1932 by 1910 pixels.
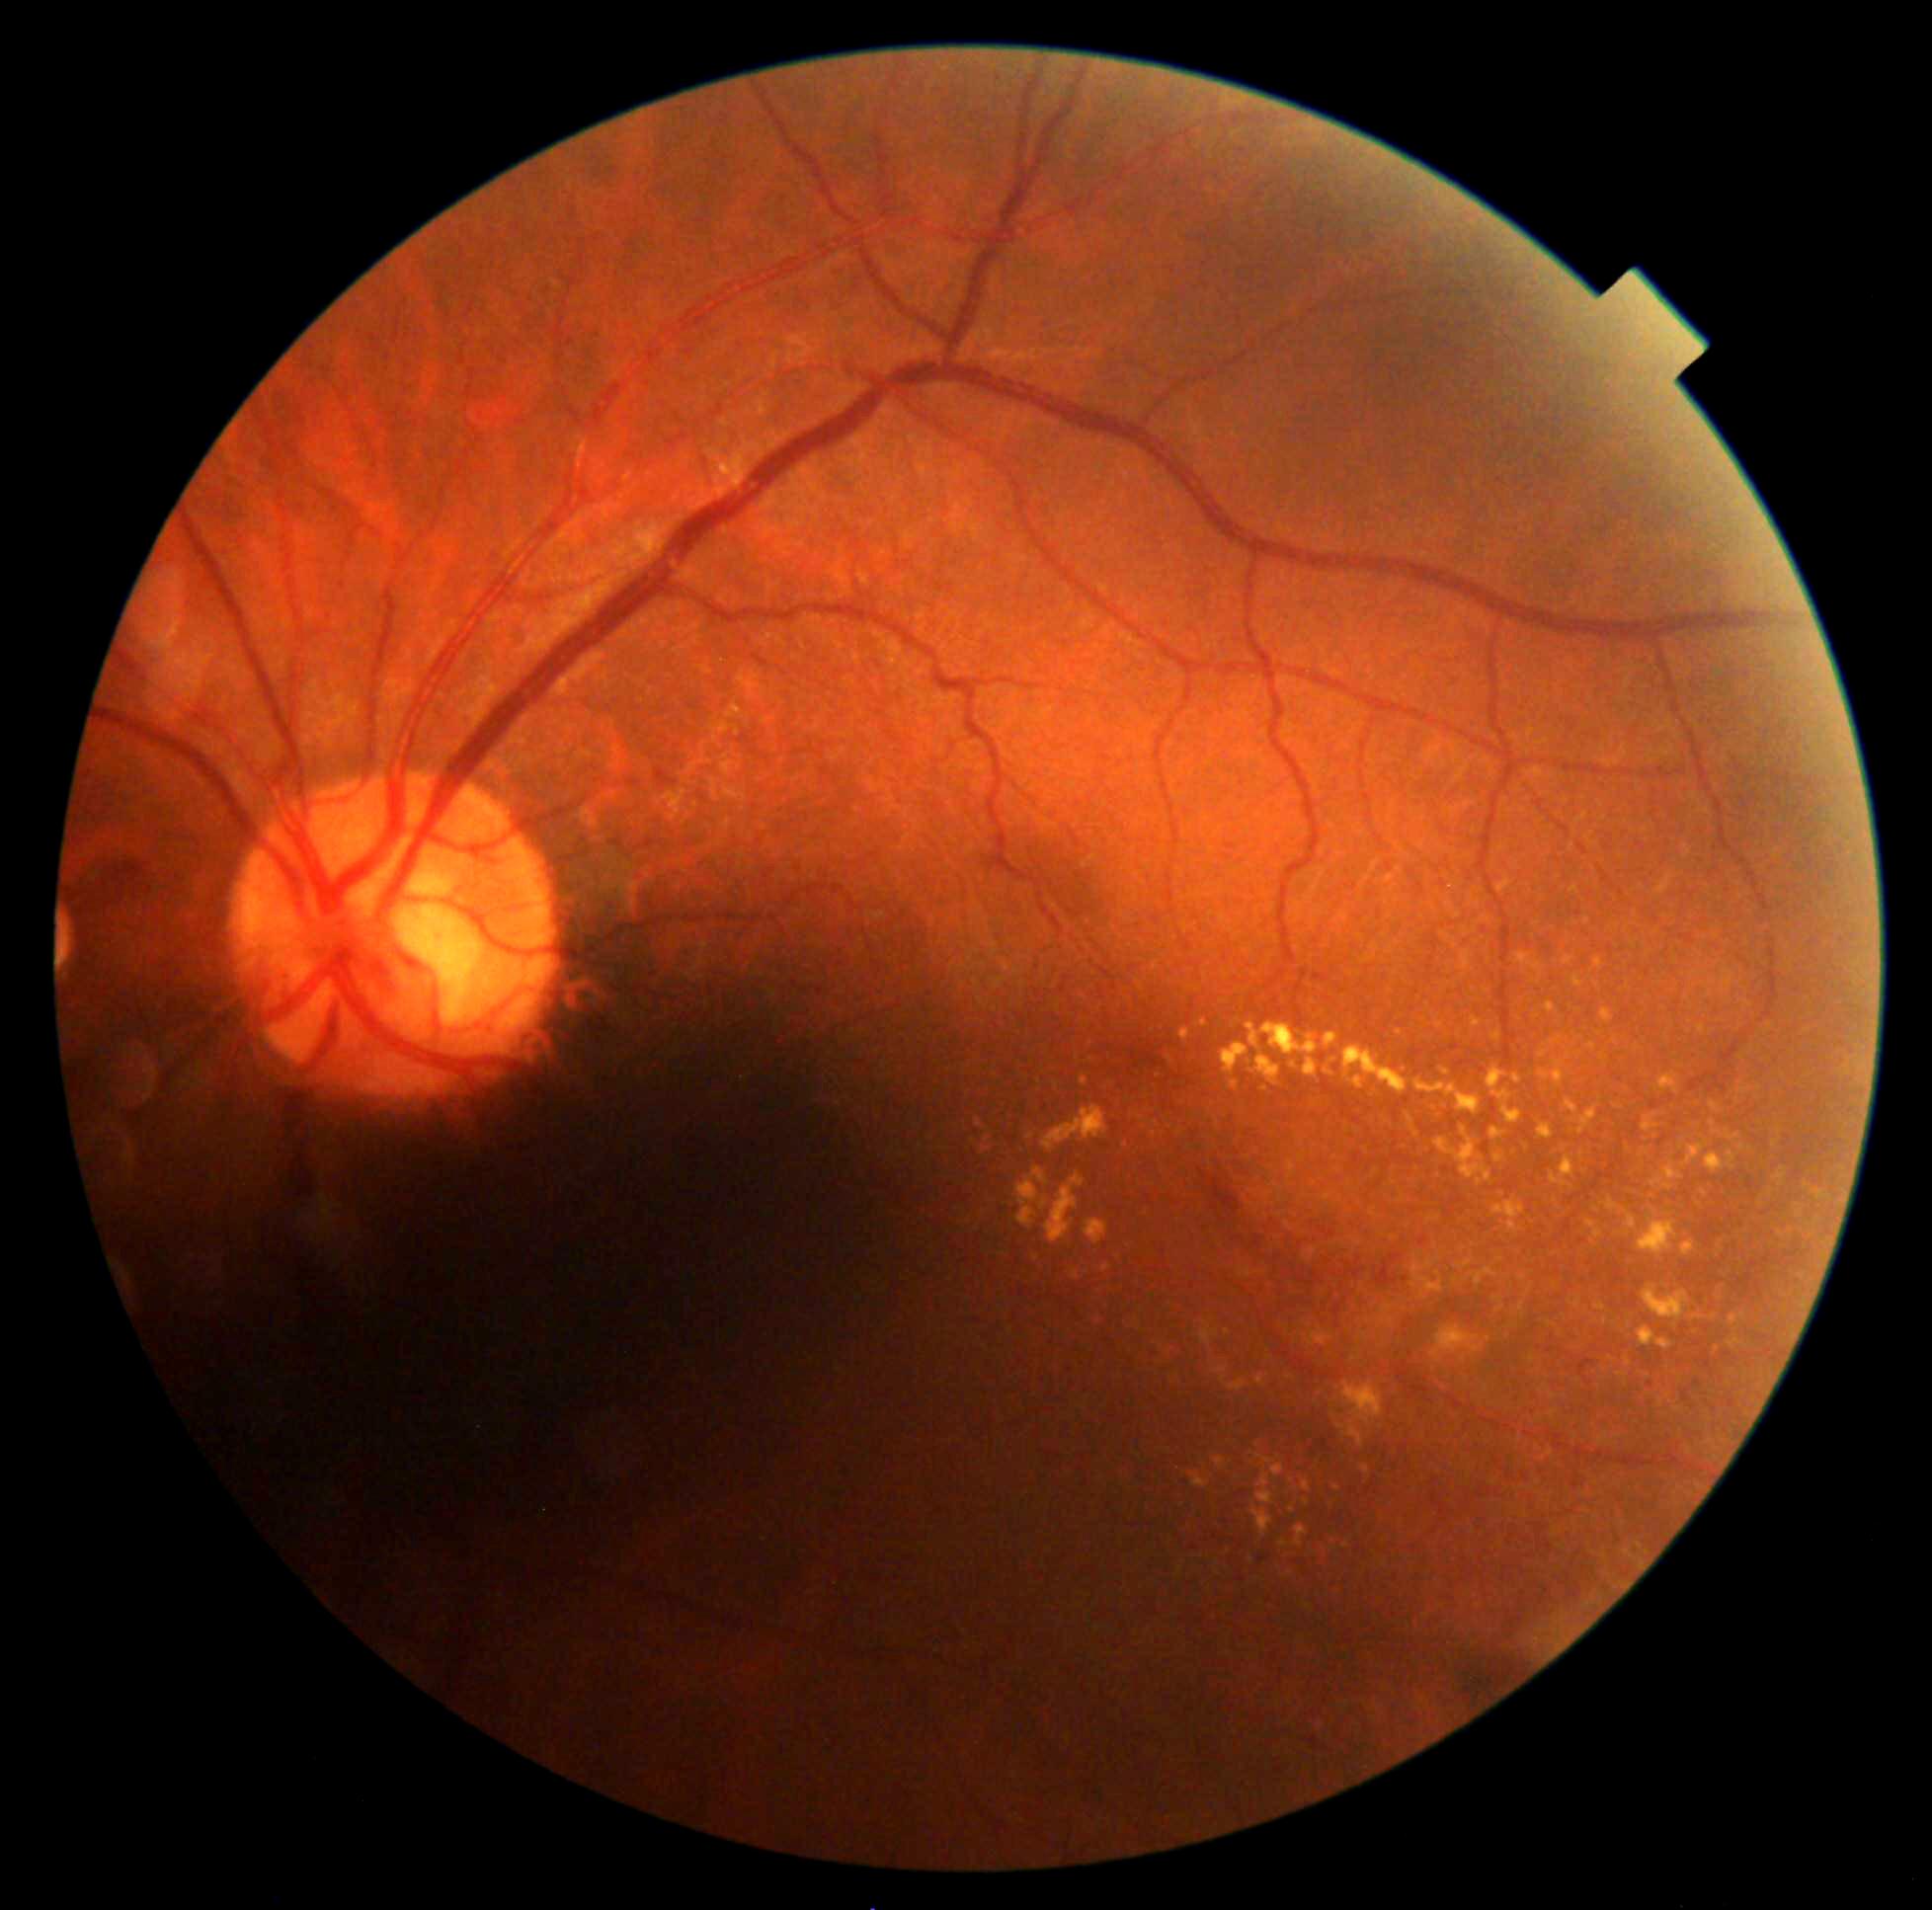 Diabetic retinopathy severity is grade 2 (moderate NPDR) — more than just microaneurysms but less than severe NPDR
Lesions identified (partial list):
hard exudates (subset) = [1214,1458,1227,1471], [1042,1105,1108,1154], [1643,1286,1691,1321], [1740,1088,1751,1094], [1257,1473,1275,1506], [1814,1191,1828,1200], [1495,1155,1506,1164], [1295,1526,1309,1548], [1337,1422,1364,1449], [1305,1605,1313,1610], [1797,1211,1802,1220], [1641,1150,1650,1158], [981,1148,990,1154], [1566,1099,1579,1116]
Additional small hard exudates near [1126,1146], [1781,1235], [1807,1187], [1251,1560], [1587,921]